Color fundus photograph centered on the optic disc:
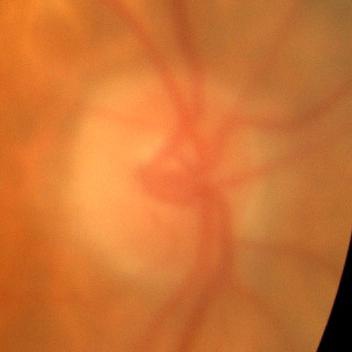
There is evidence of no glaucomatous optic neuropathy.